Captured after pupil dilation · posterior pole view
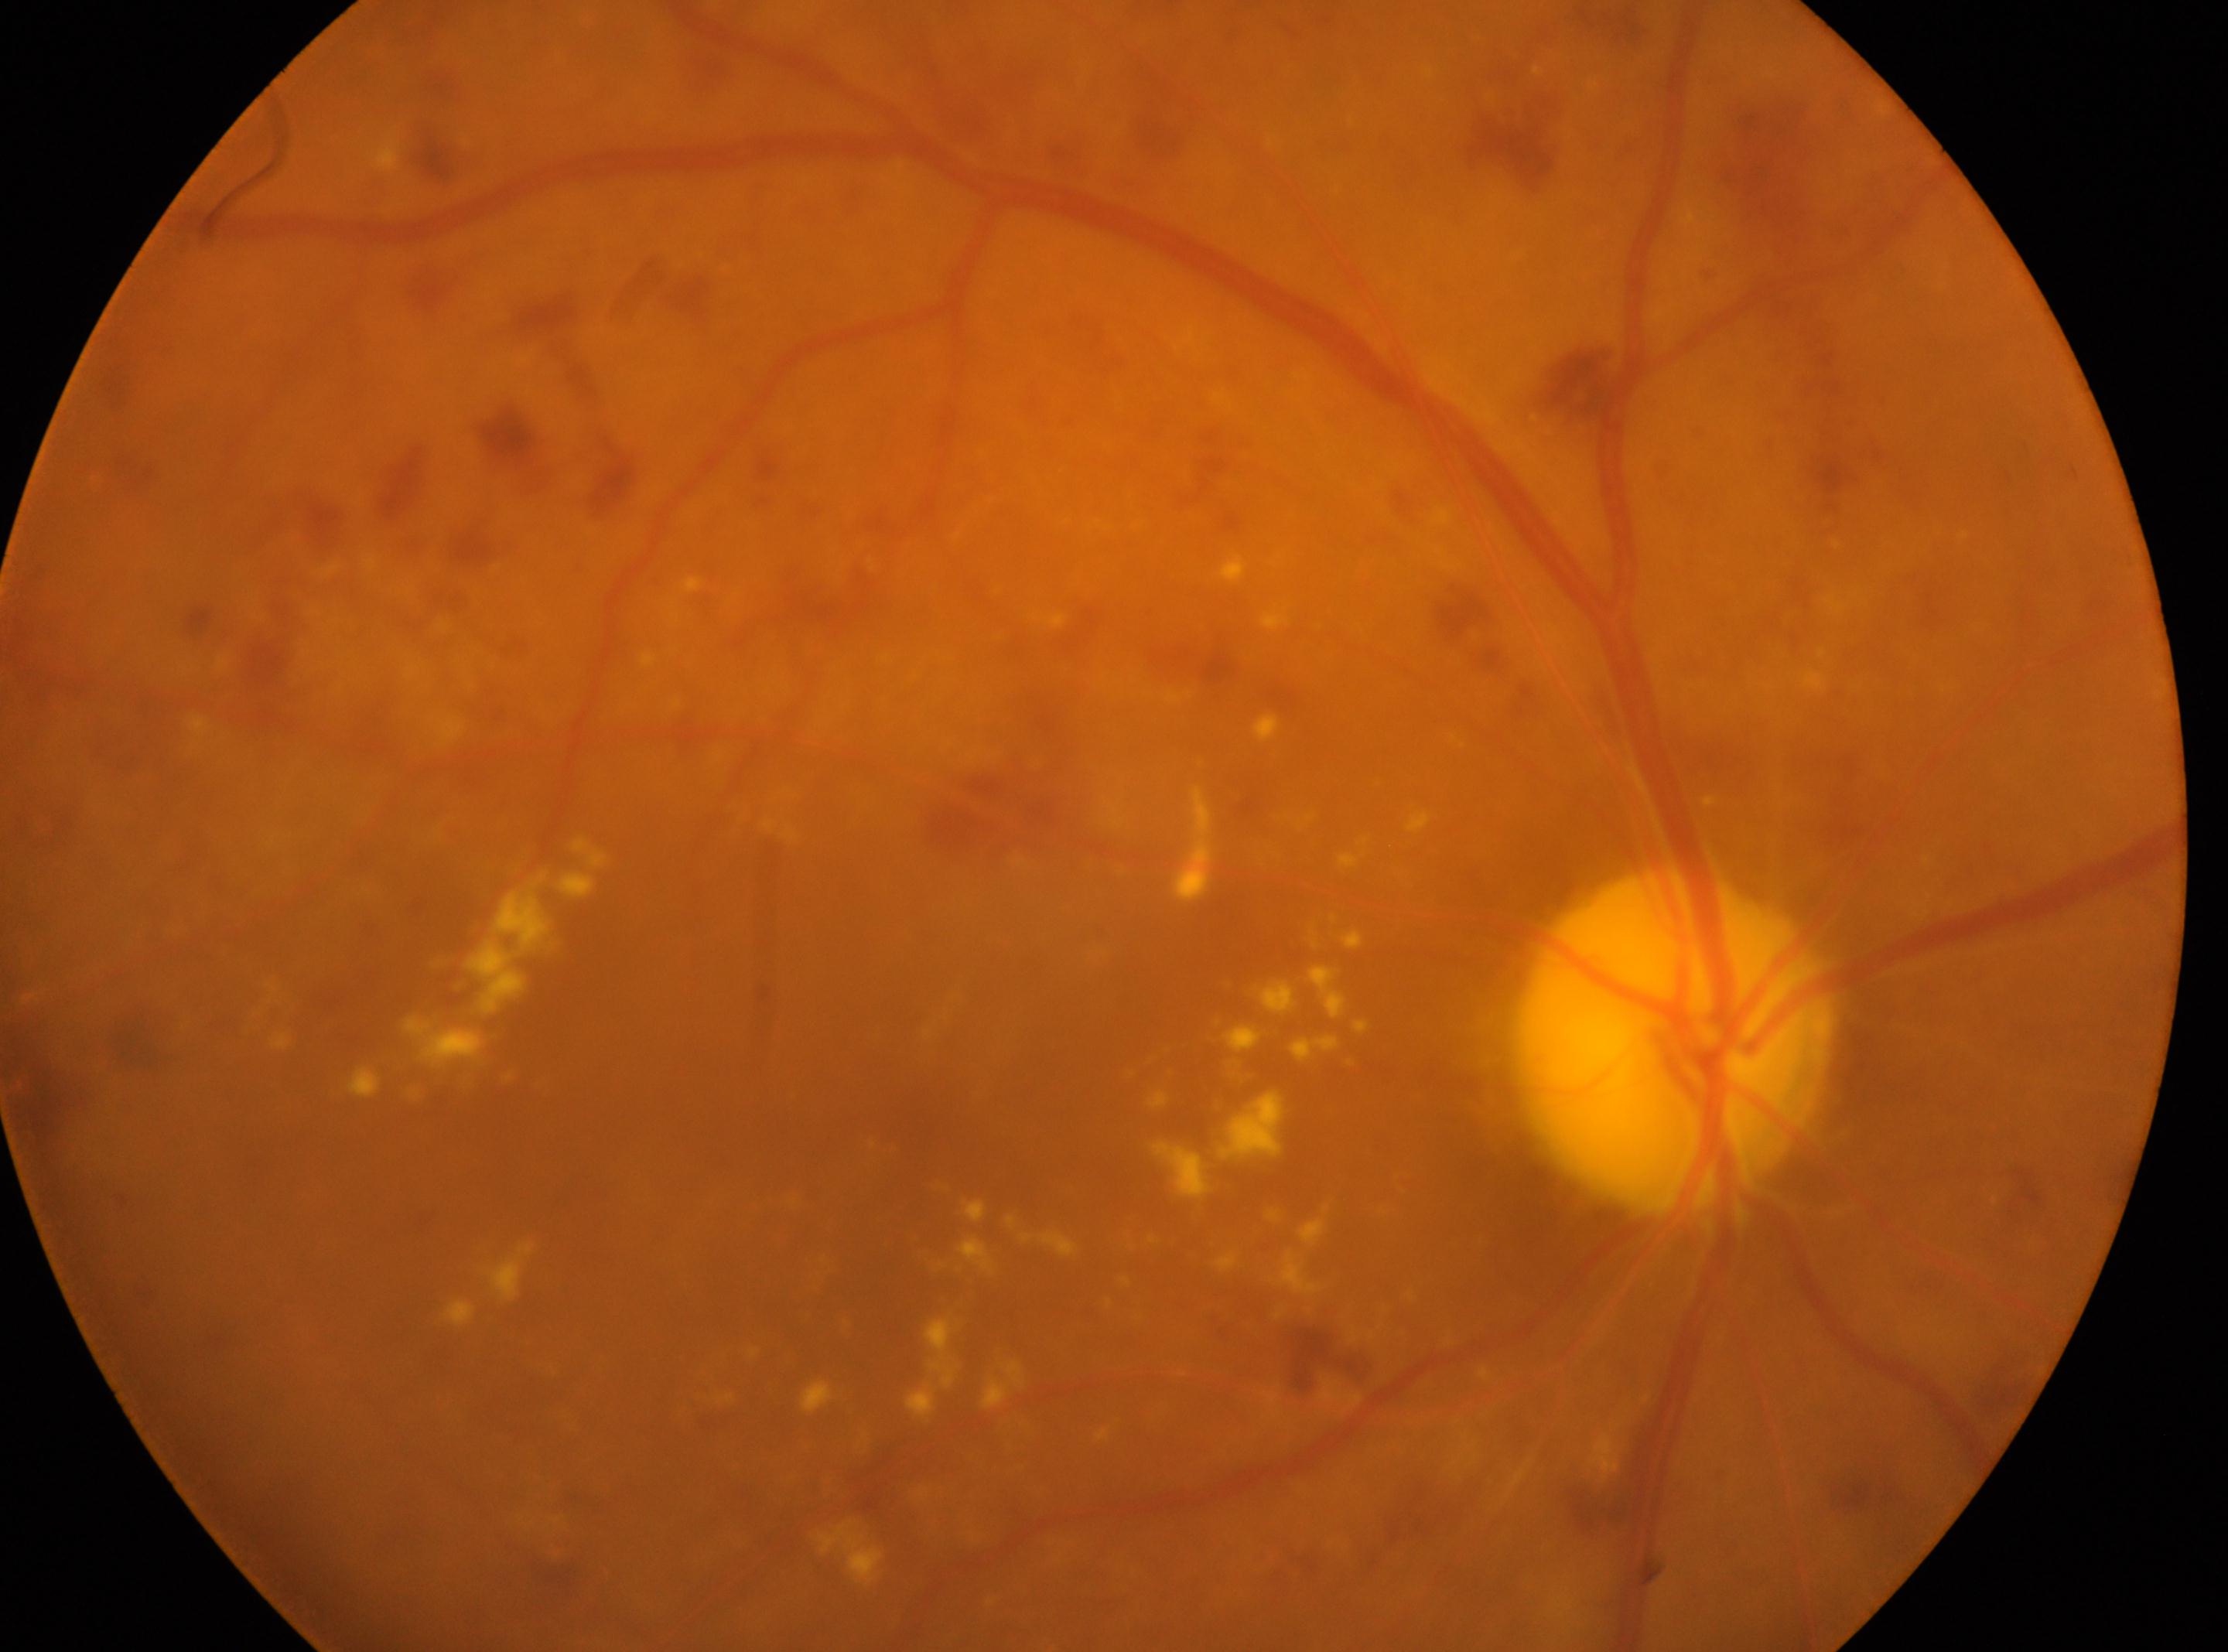 right; non-proliferative diabetic retinopathy; optic nerve head: x=1674, y=1043; fovea center: x=893, y=1118; retinopathy grade: severe non-proliferative diabetic retinopathy (3).